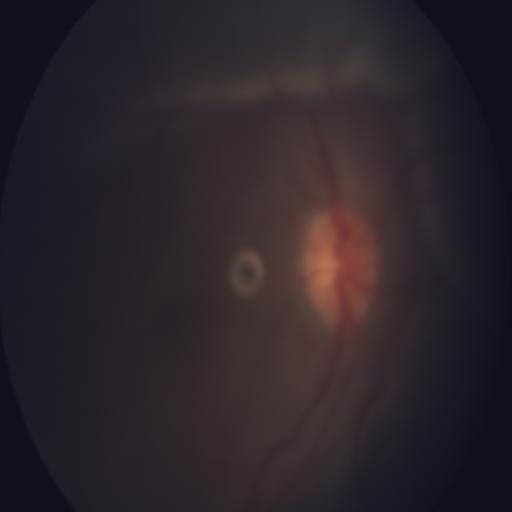

Showing optic disc edema & media haze.